FOV: 45 degrees.
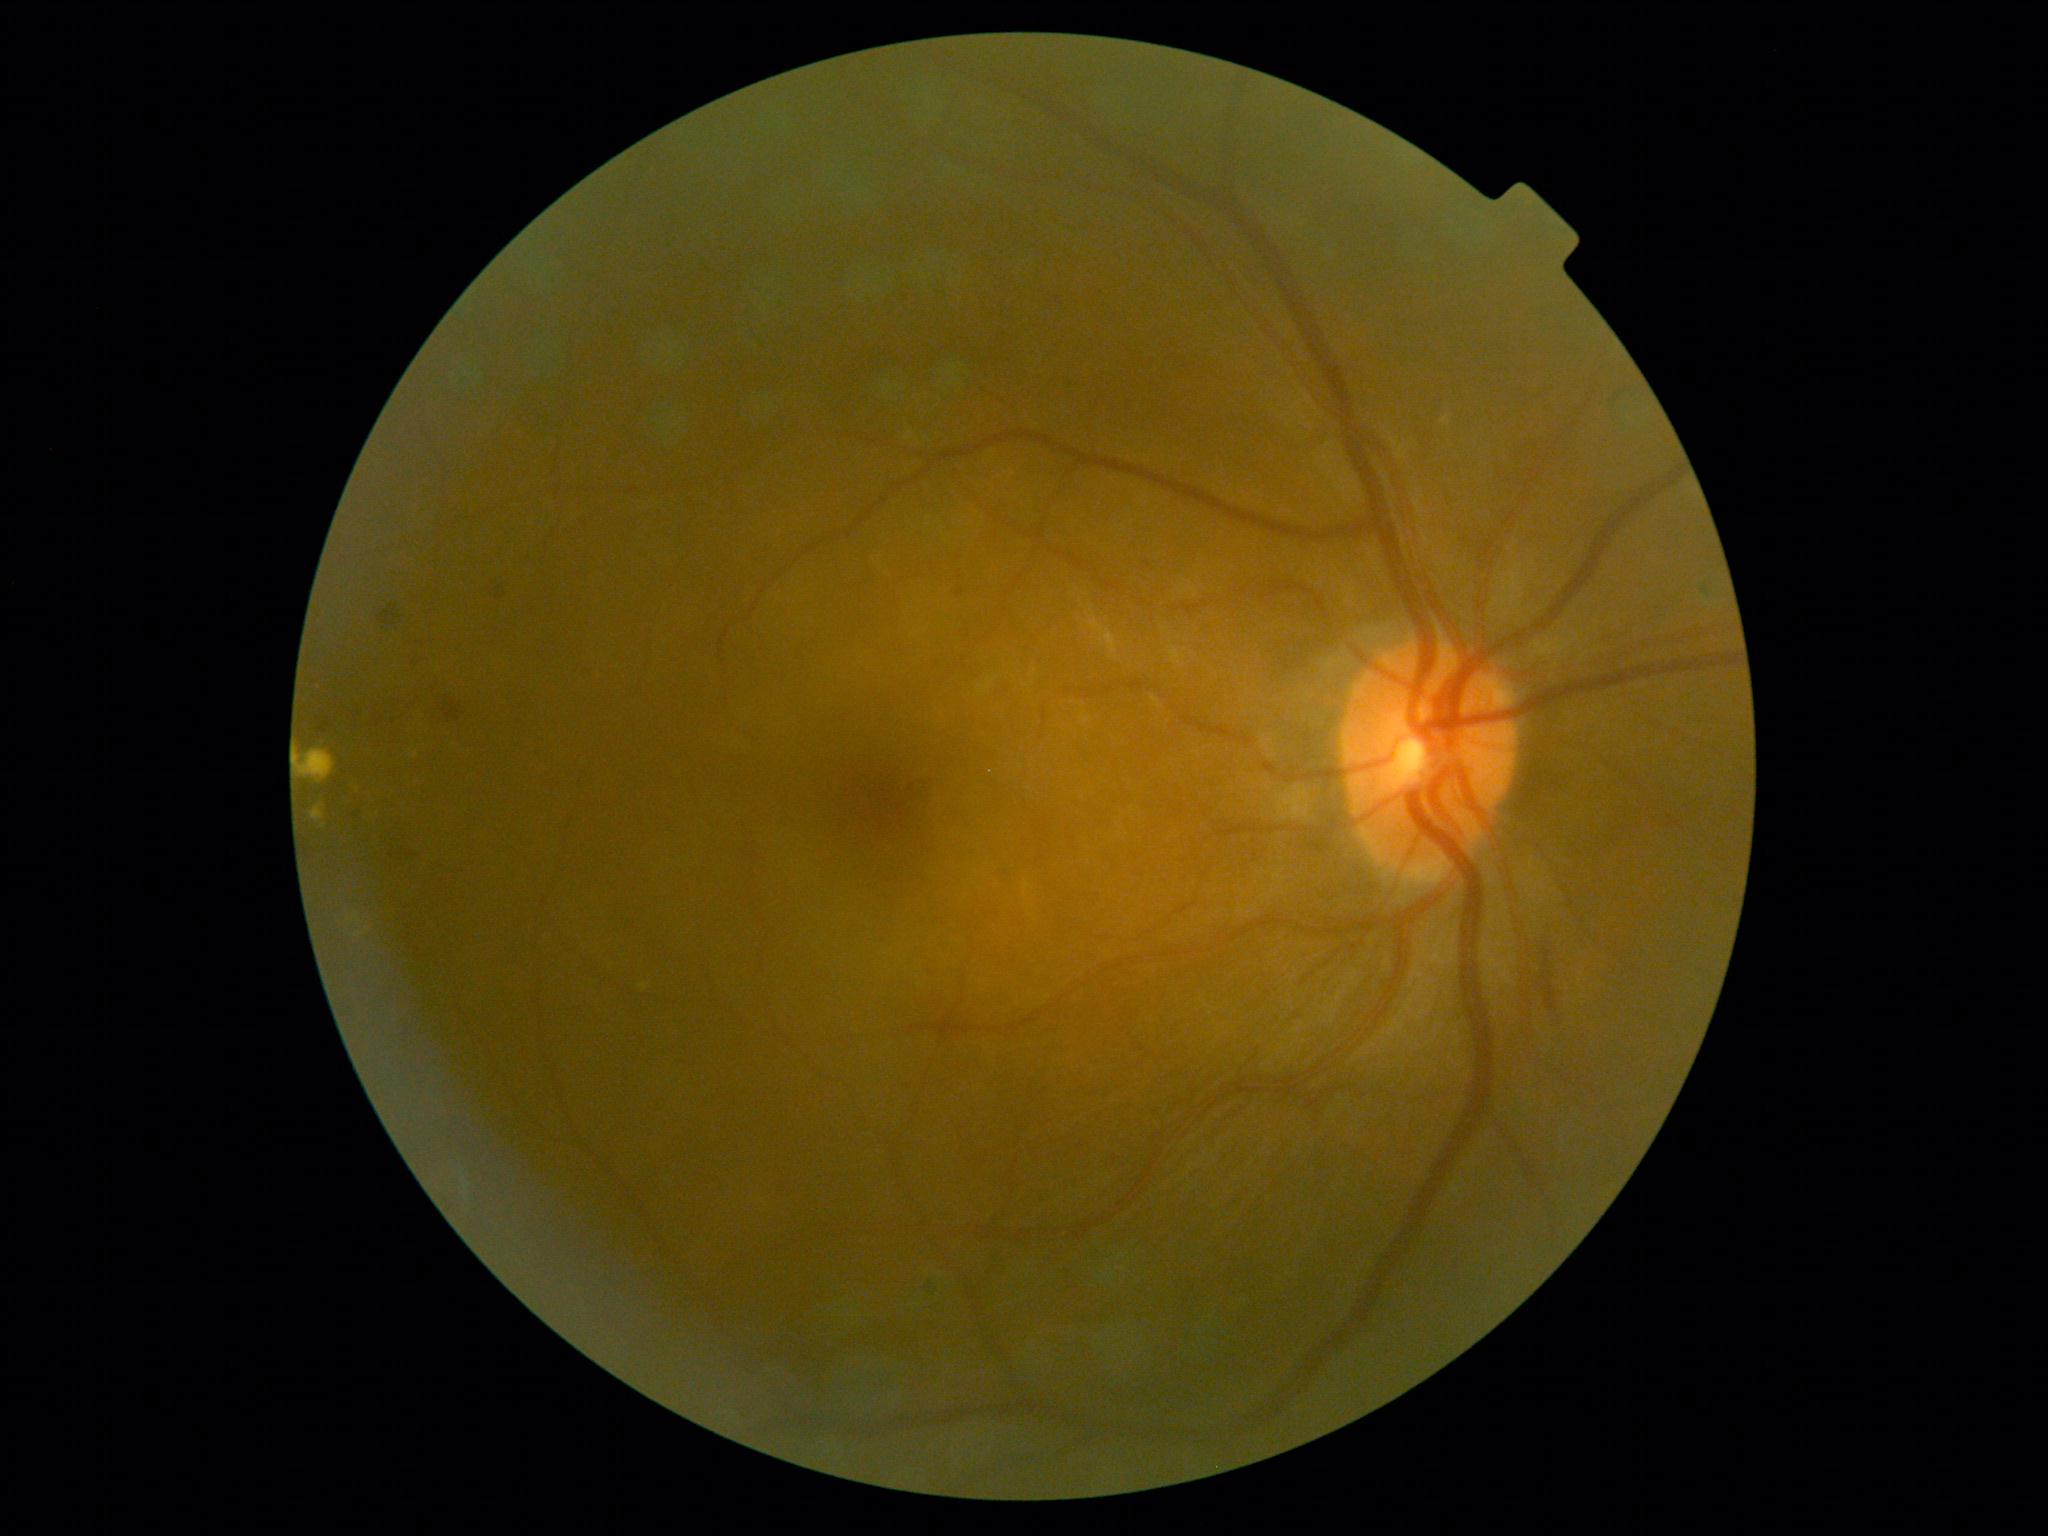 The retinopathy is classified as non-proliferative diabetic retinopathy. Diabetic retinopathy grade is 2.